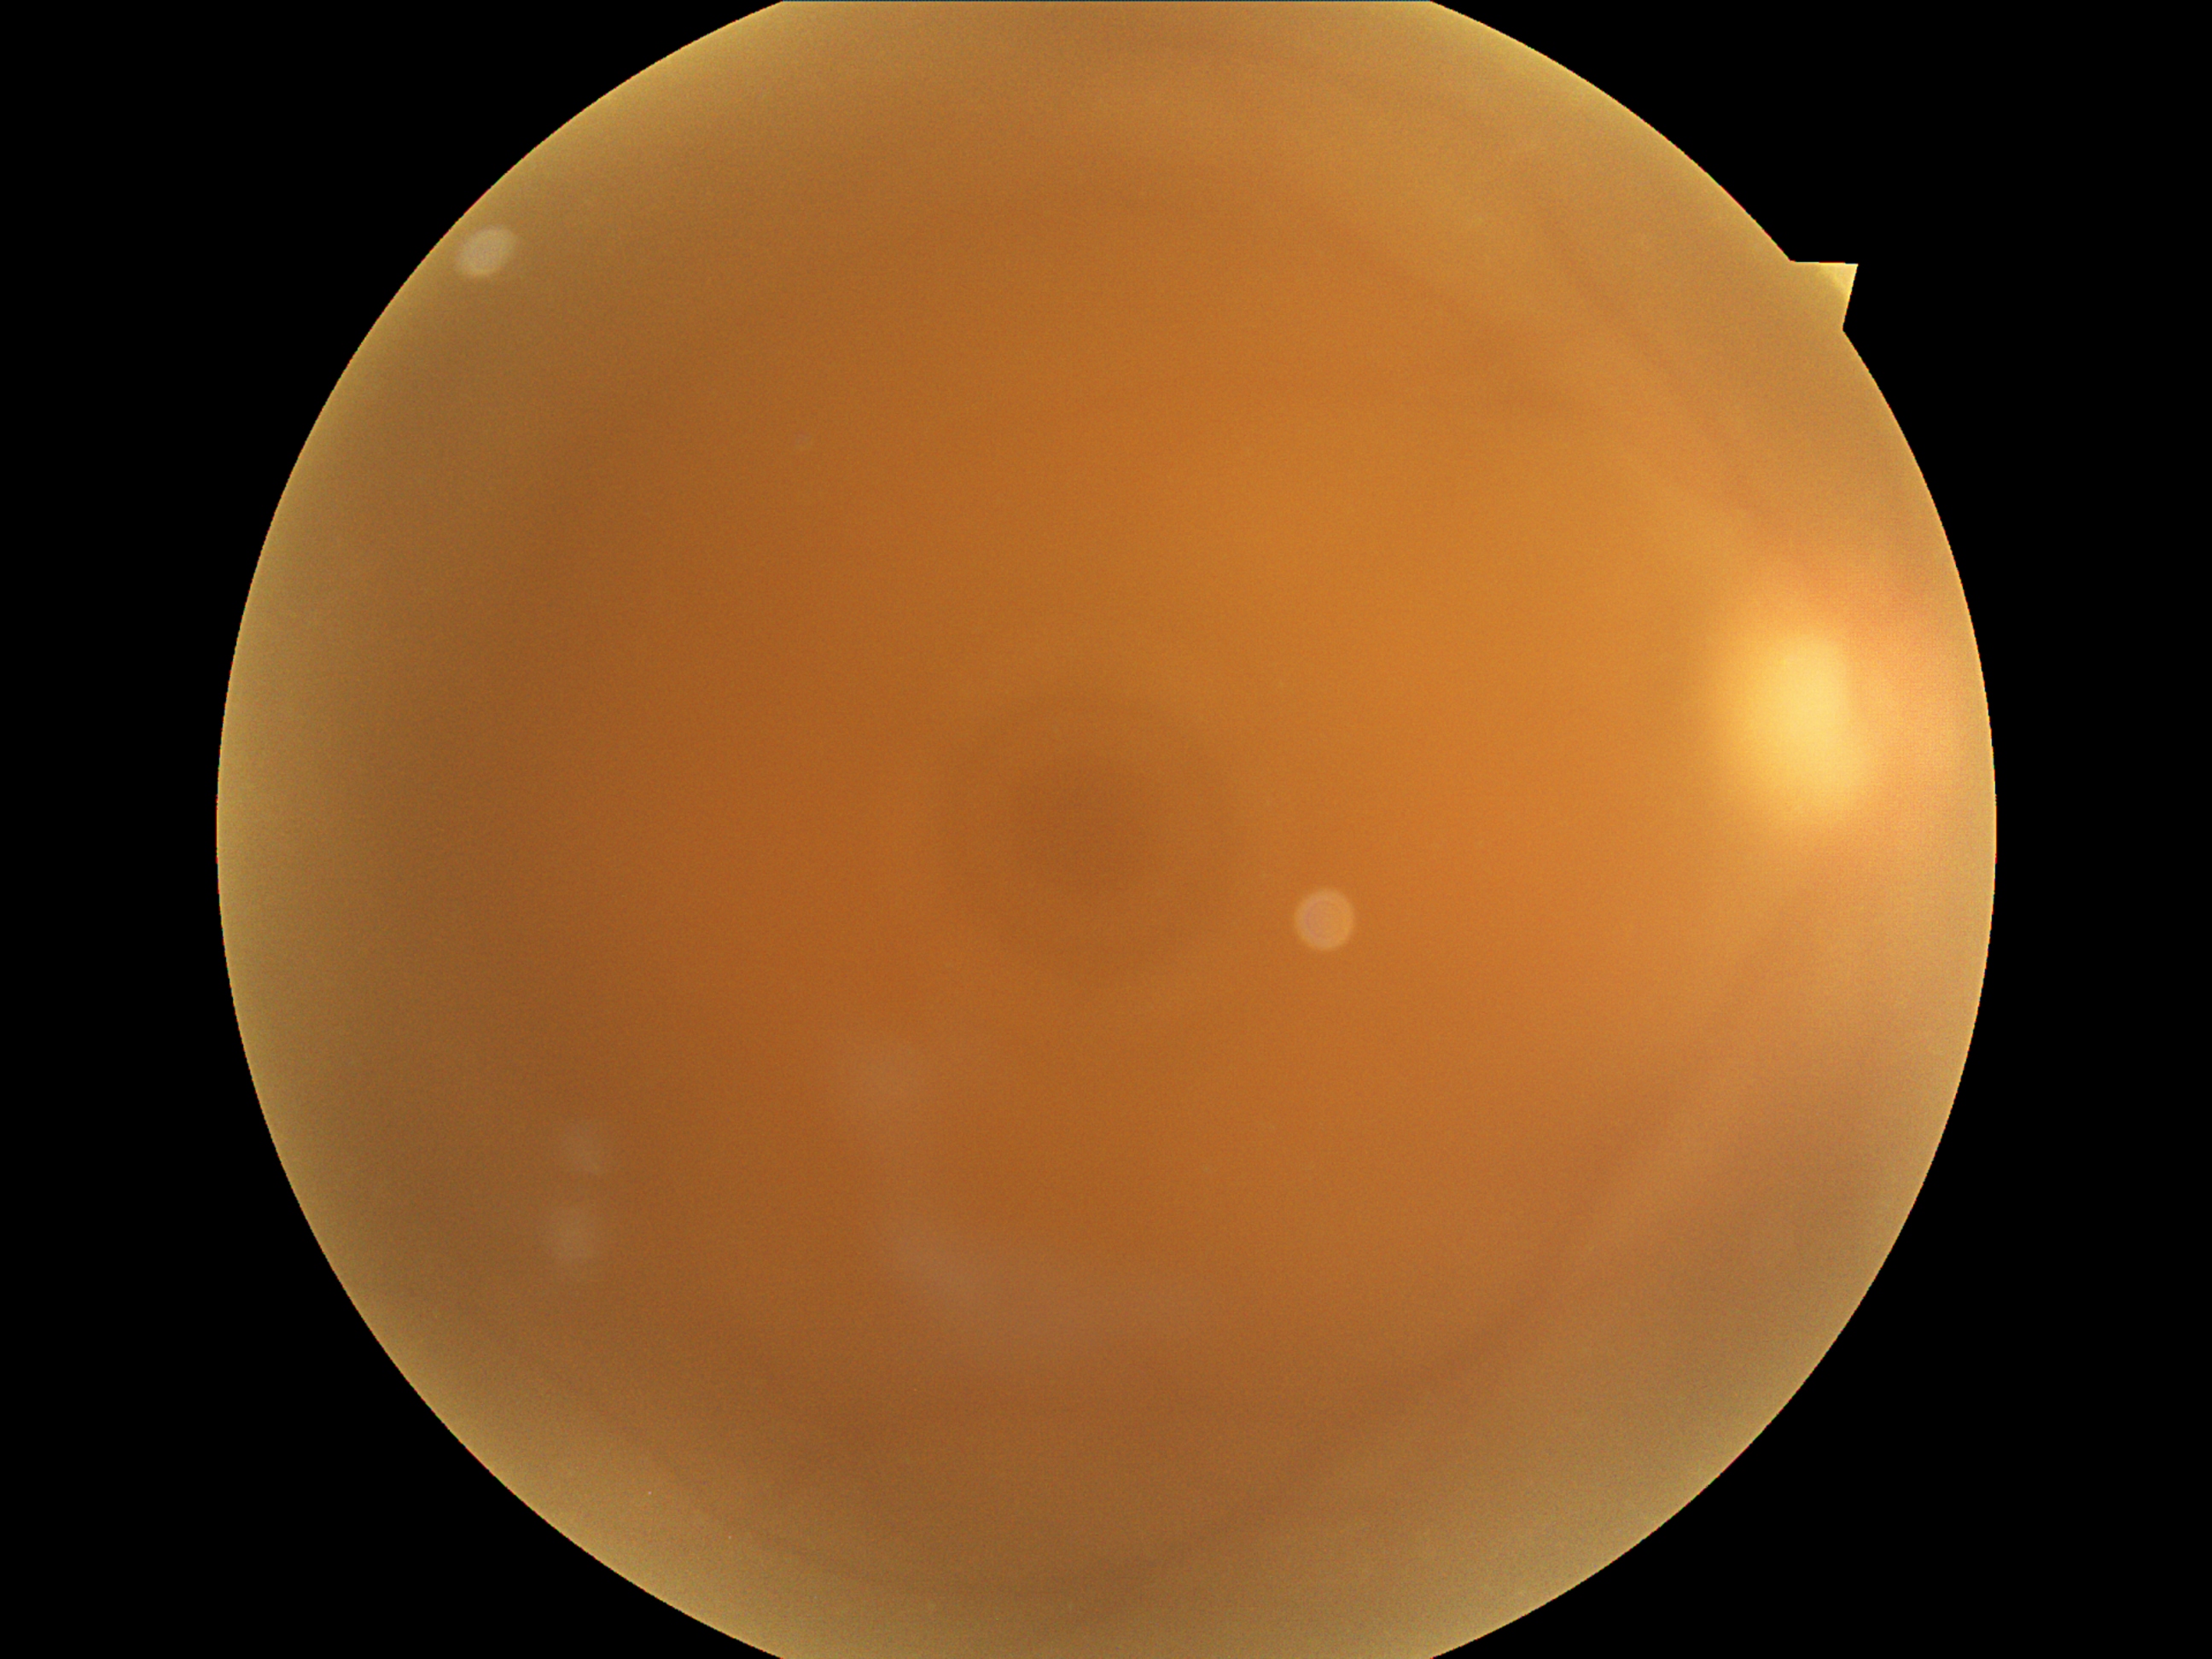

DR: ungradable.